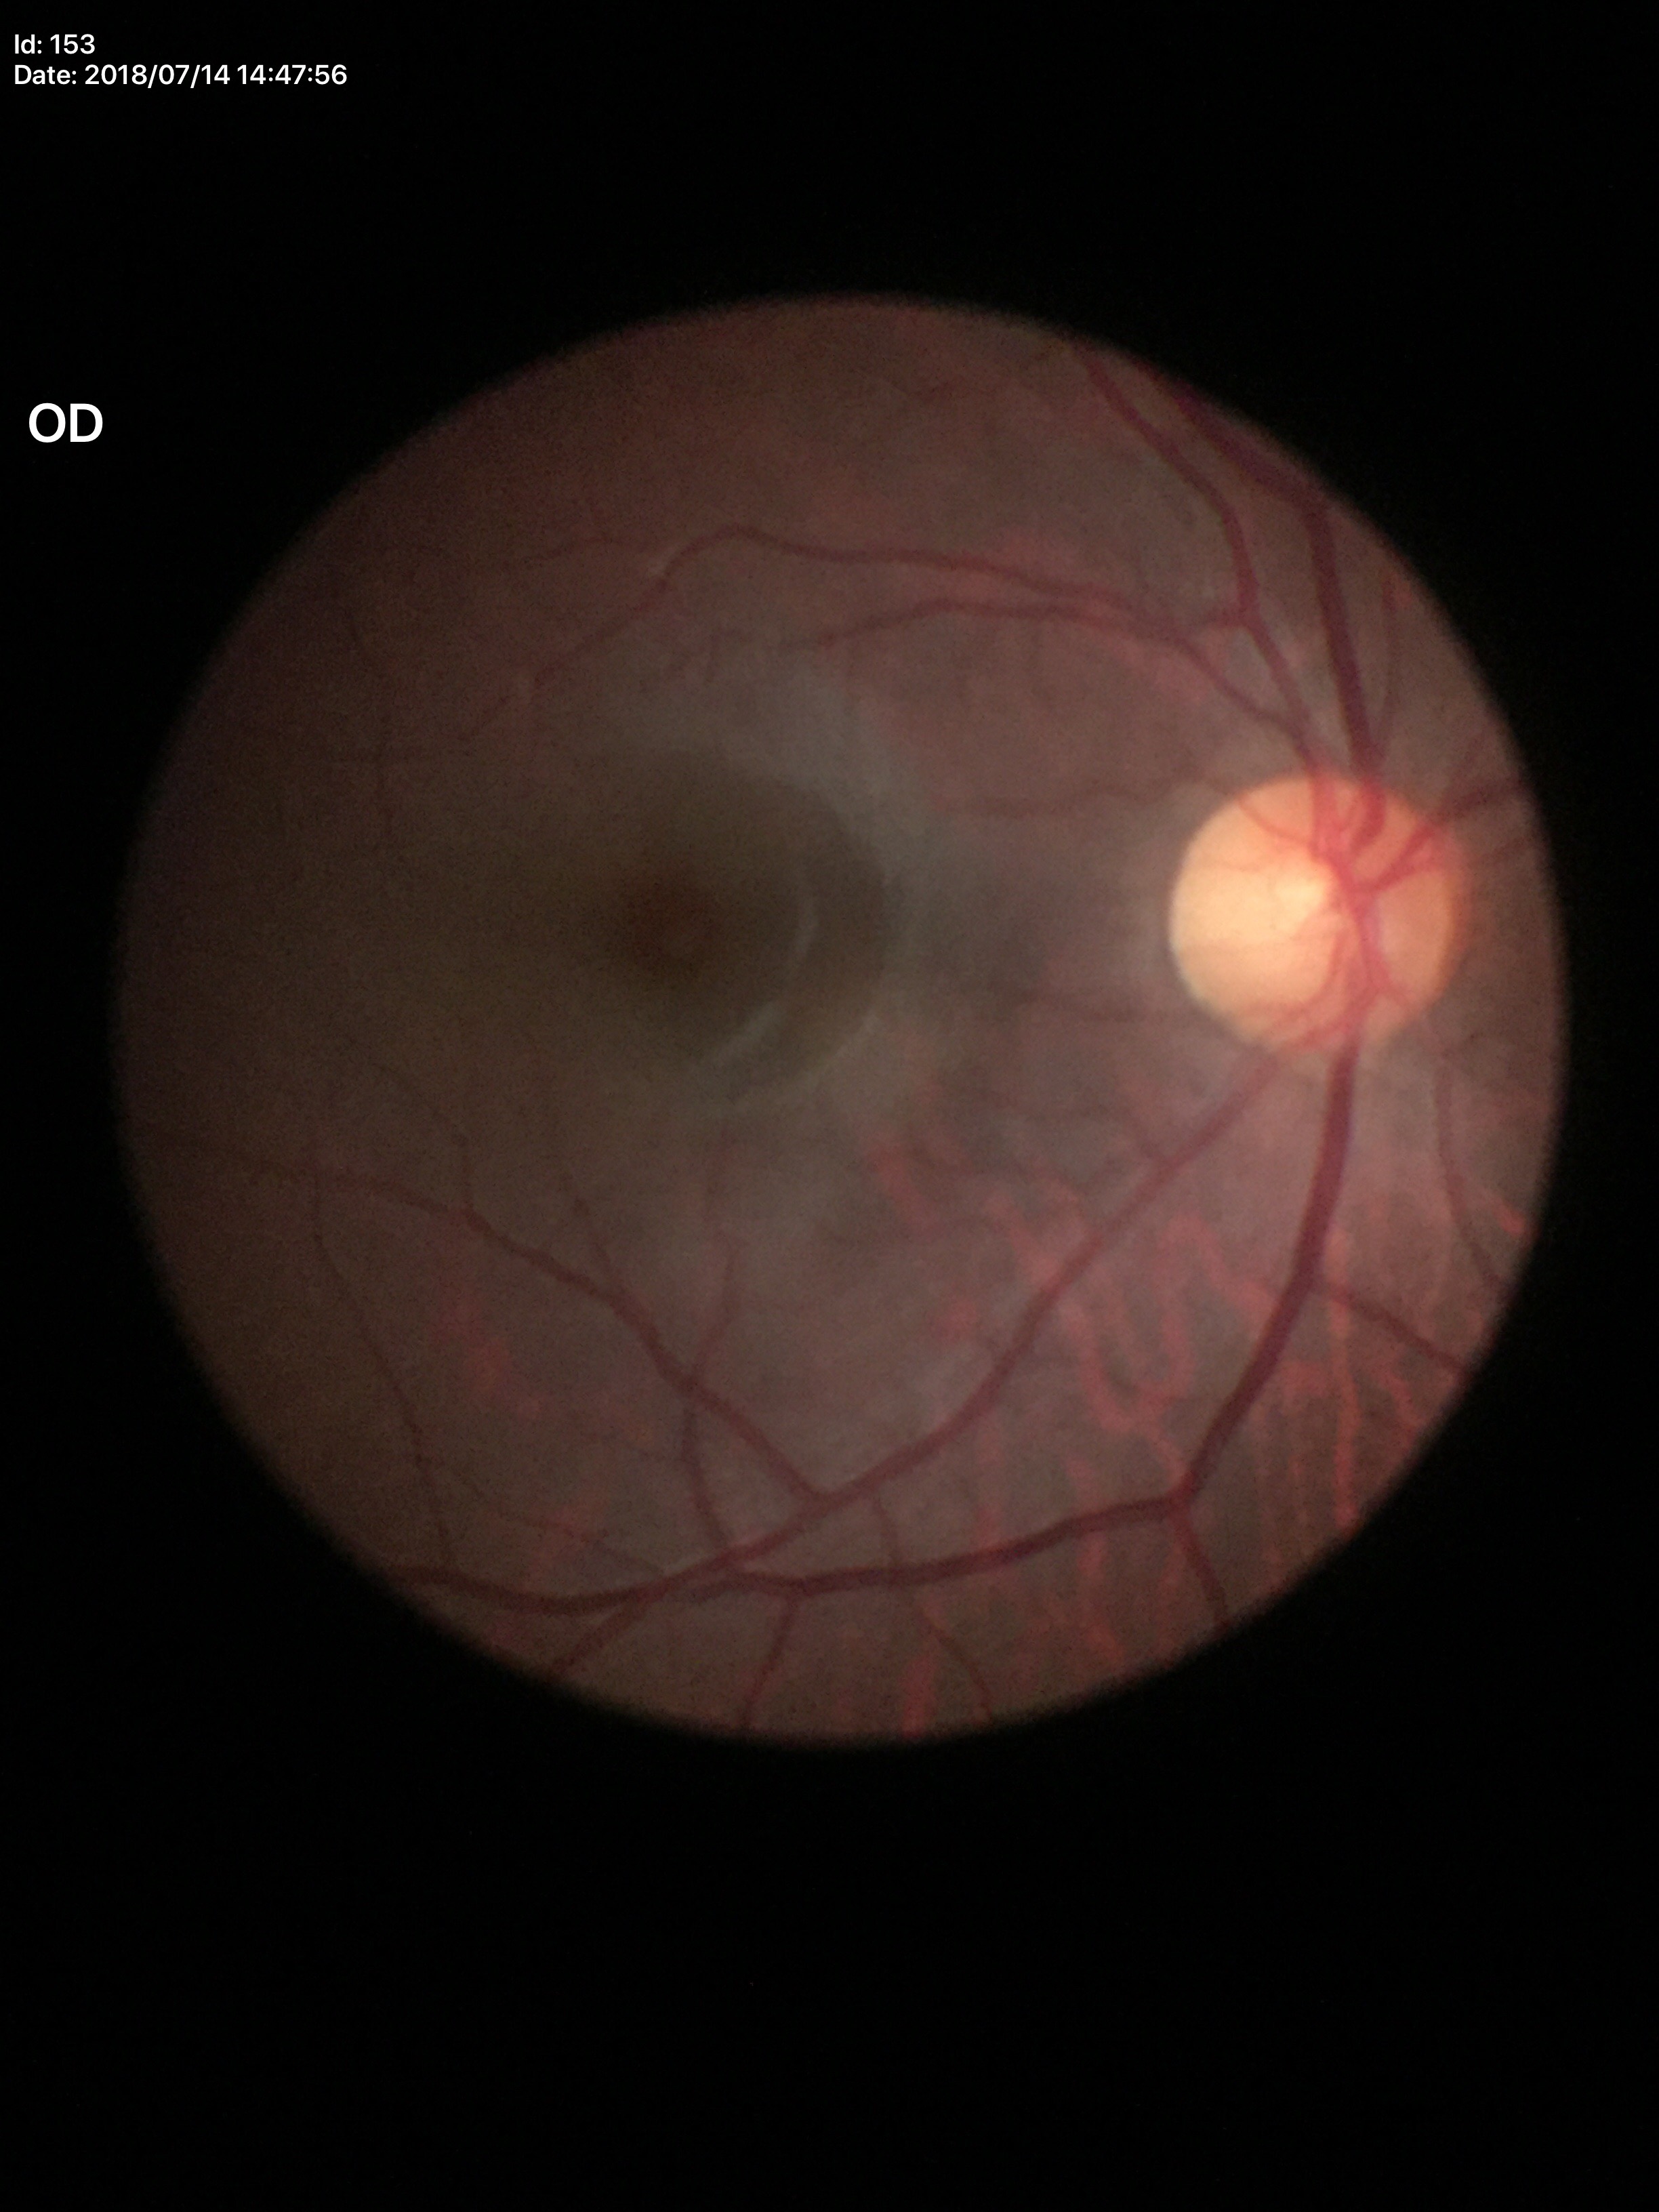

{
  "glaucoma_decision": "no suspicious findings",
  "vcdr": "0.50",
  "hcdr": "0.48"
}